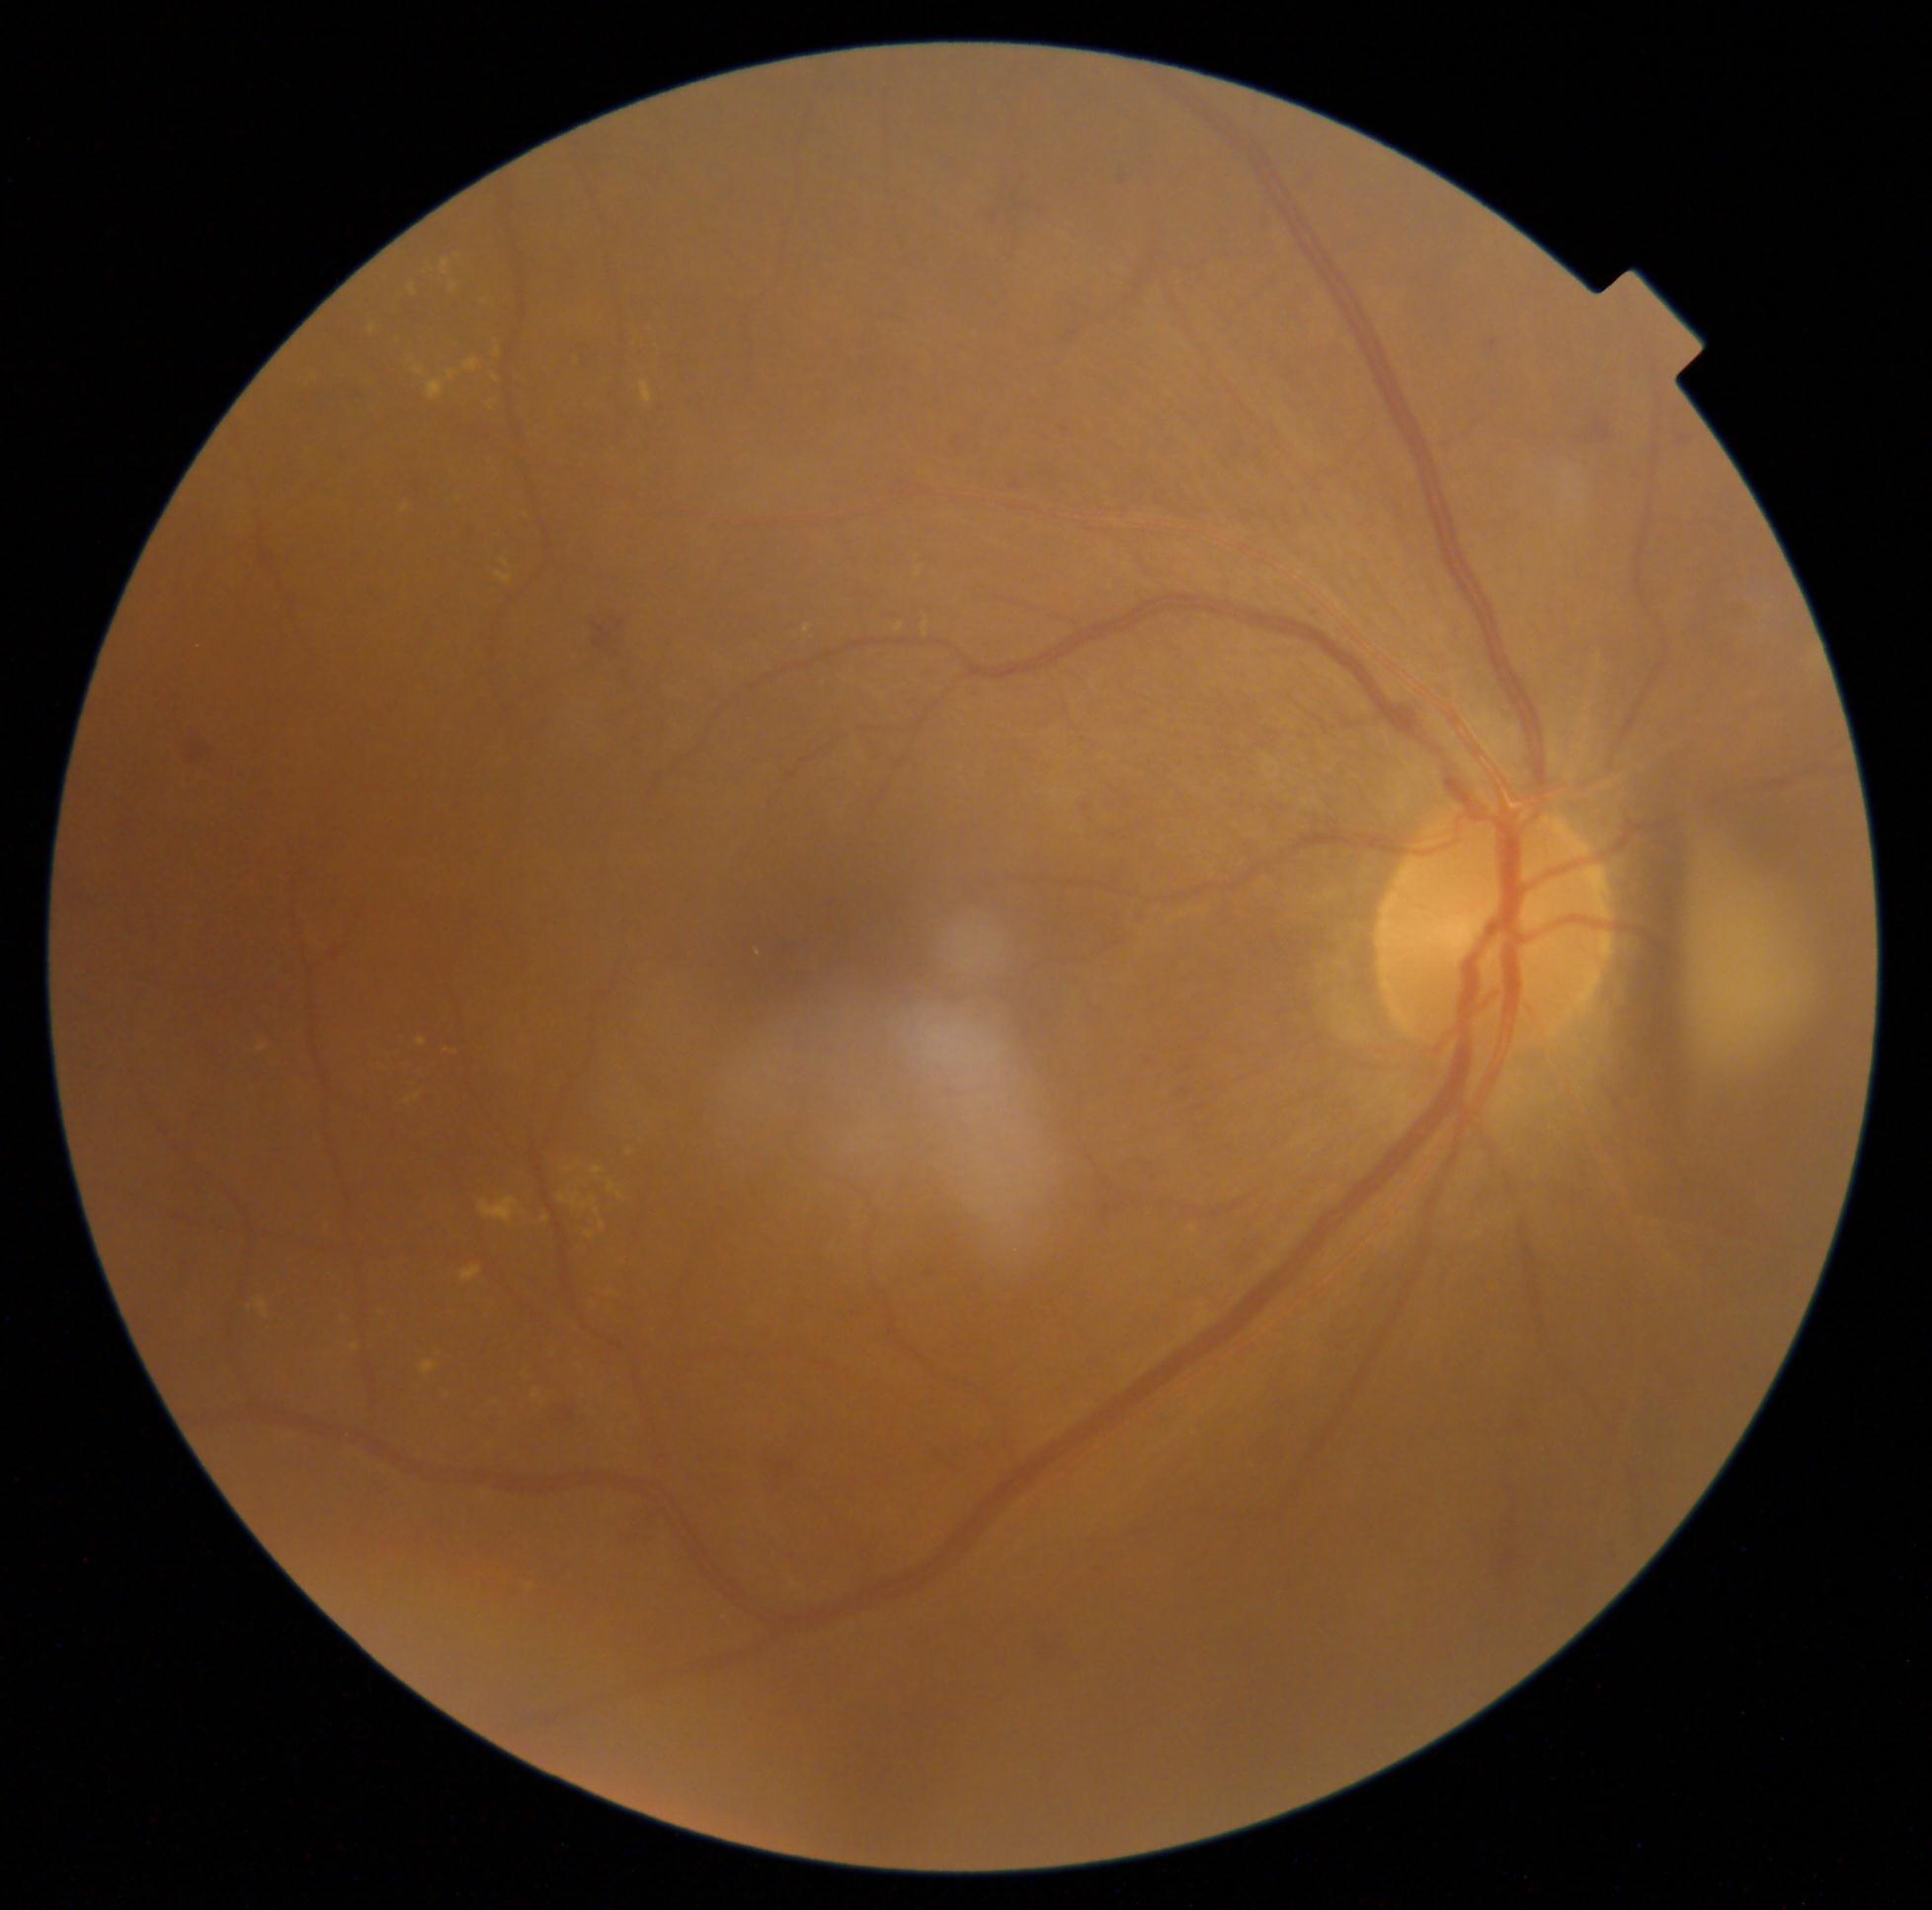

Diabetic retinopathy (DR) is grade 2; non-proliferative diabetic retinopathy.
No microaneurysms (MAs) identified.
Hard exudates (EXs) include lesions at <bbox>570, 1195, 579, 1208</bbox>, <bbox>642, 383, 654, 405</bbox>, <bbox>411, 284, 416, 295</bbox>, <bbox>420, 265, 436, 278</bbox>, <bbox>415, 368, 424, 376</bbox>, <bbox>586, 1233, 596, 1239</bbox>, <bbox>581, 1204, 590, 1209</bbox>, <bbox>481, 1198, 519, 1224</bbox>, <bbox>257, 1045, 268, 1052</bbox>, <bbox>431, 1349, 443, 1363</bbox>, <bbox>592, 1166, 605, 1175</bbox>, <bbox>450, 282, 457, 291</bbox>, <bbox>411, 1066, 425, 1076</bbox>.
Additional small EXs near x=446, y=1052, x=619, y=1196, x=630, y=1153, x=759, y=953.
Hemorrhages (HEs) include lesions at <bbox>1108, 169, 1125, 194</bbox>, <bbox>545, 1398, 577, 1431</bbox>, <bbox>620, 1497, 654, 1549</bbox>, <bbox>592, 603, 627, 662</bbox>, <bbox>896, 476, 916, 494</bbox>, <bbox>1134, 1164, 1161, 1188</bbox>, <bbox>1055, 421, 1080, 435</bbox>, <bbox>1679, 437, 1690, 447</bbox>, <bbox>1491, 340, 1498, 350</bbox>, <bbox>982, 161, 1053, 265</bbox>, <bbox>1593, 421, 1611, 442</bbox>, <bbox>177, 730, 215, 760</bbox>, <bbox>1006, 474, 1022, 494</bbox>, <bbox>1098, 1191, 1127, 1219</bbox>, <bbox>760, 1438, 799, 1493</bbox>, <bbox>1493, 1472, 1527, 1605</bbox>, <bbox>1033, 1614, 1088, 1674</bbox>.
Additional small HEs near x=1589, y=442.
No soft exudates (SEs) identified.